268x268px; optic disc-centered crop from a color fundus photograph; 35° field of view before cropping: 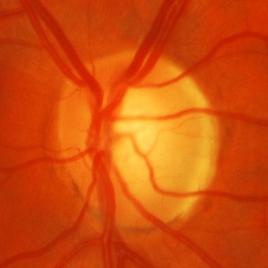 Glaucomatous optic neuropathy is present. Demonstrates glaucomatous optic neuropathy.